Image size 848x848; nonmydriatic; fundus photo; 45-degree field of view
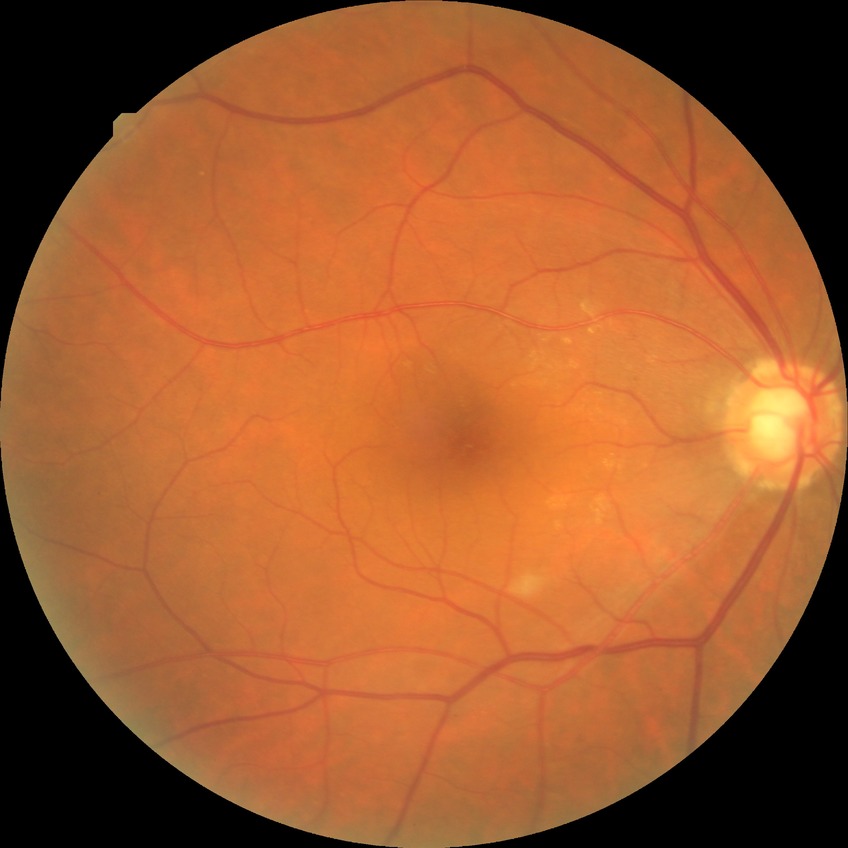

DR class = non-proliferative diabetic retinopathy | diabetic retinopathy (DR) = SDR (simple diabetic retinopathy).